45-degree field of view · image size 2352x1568: 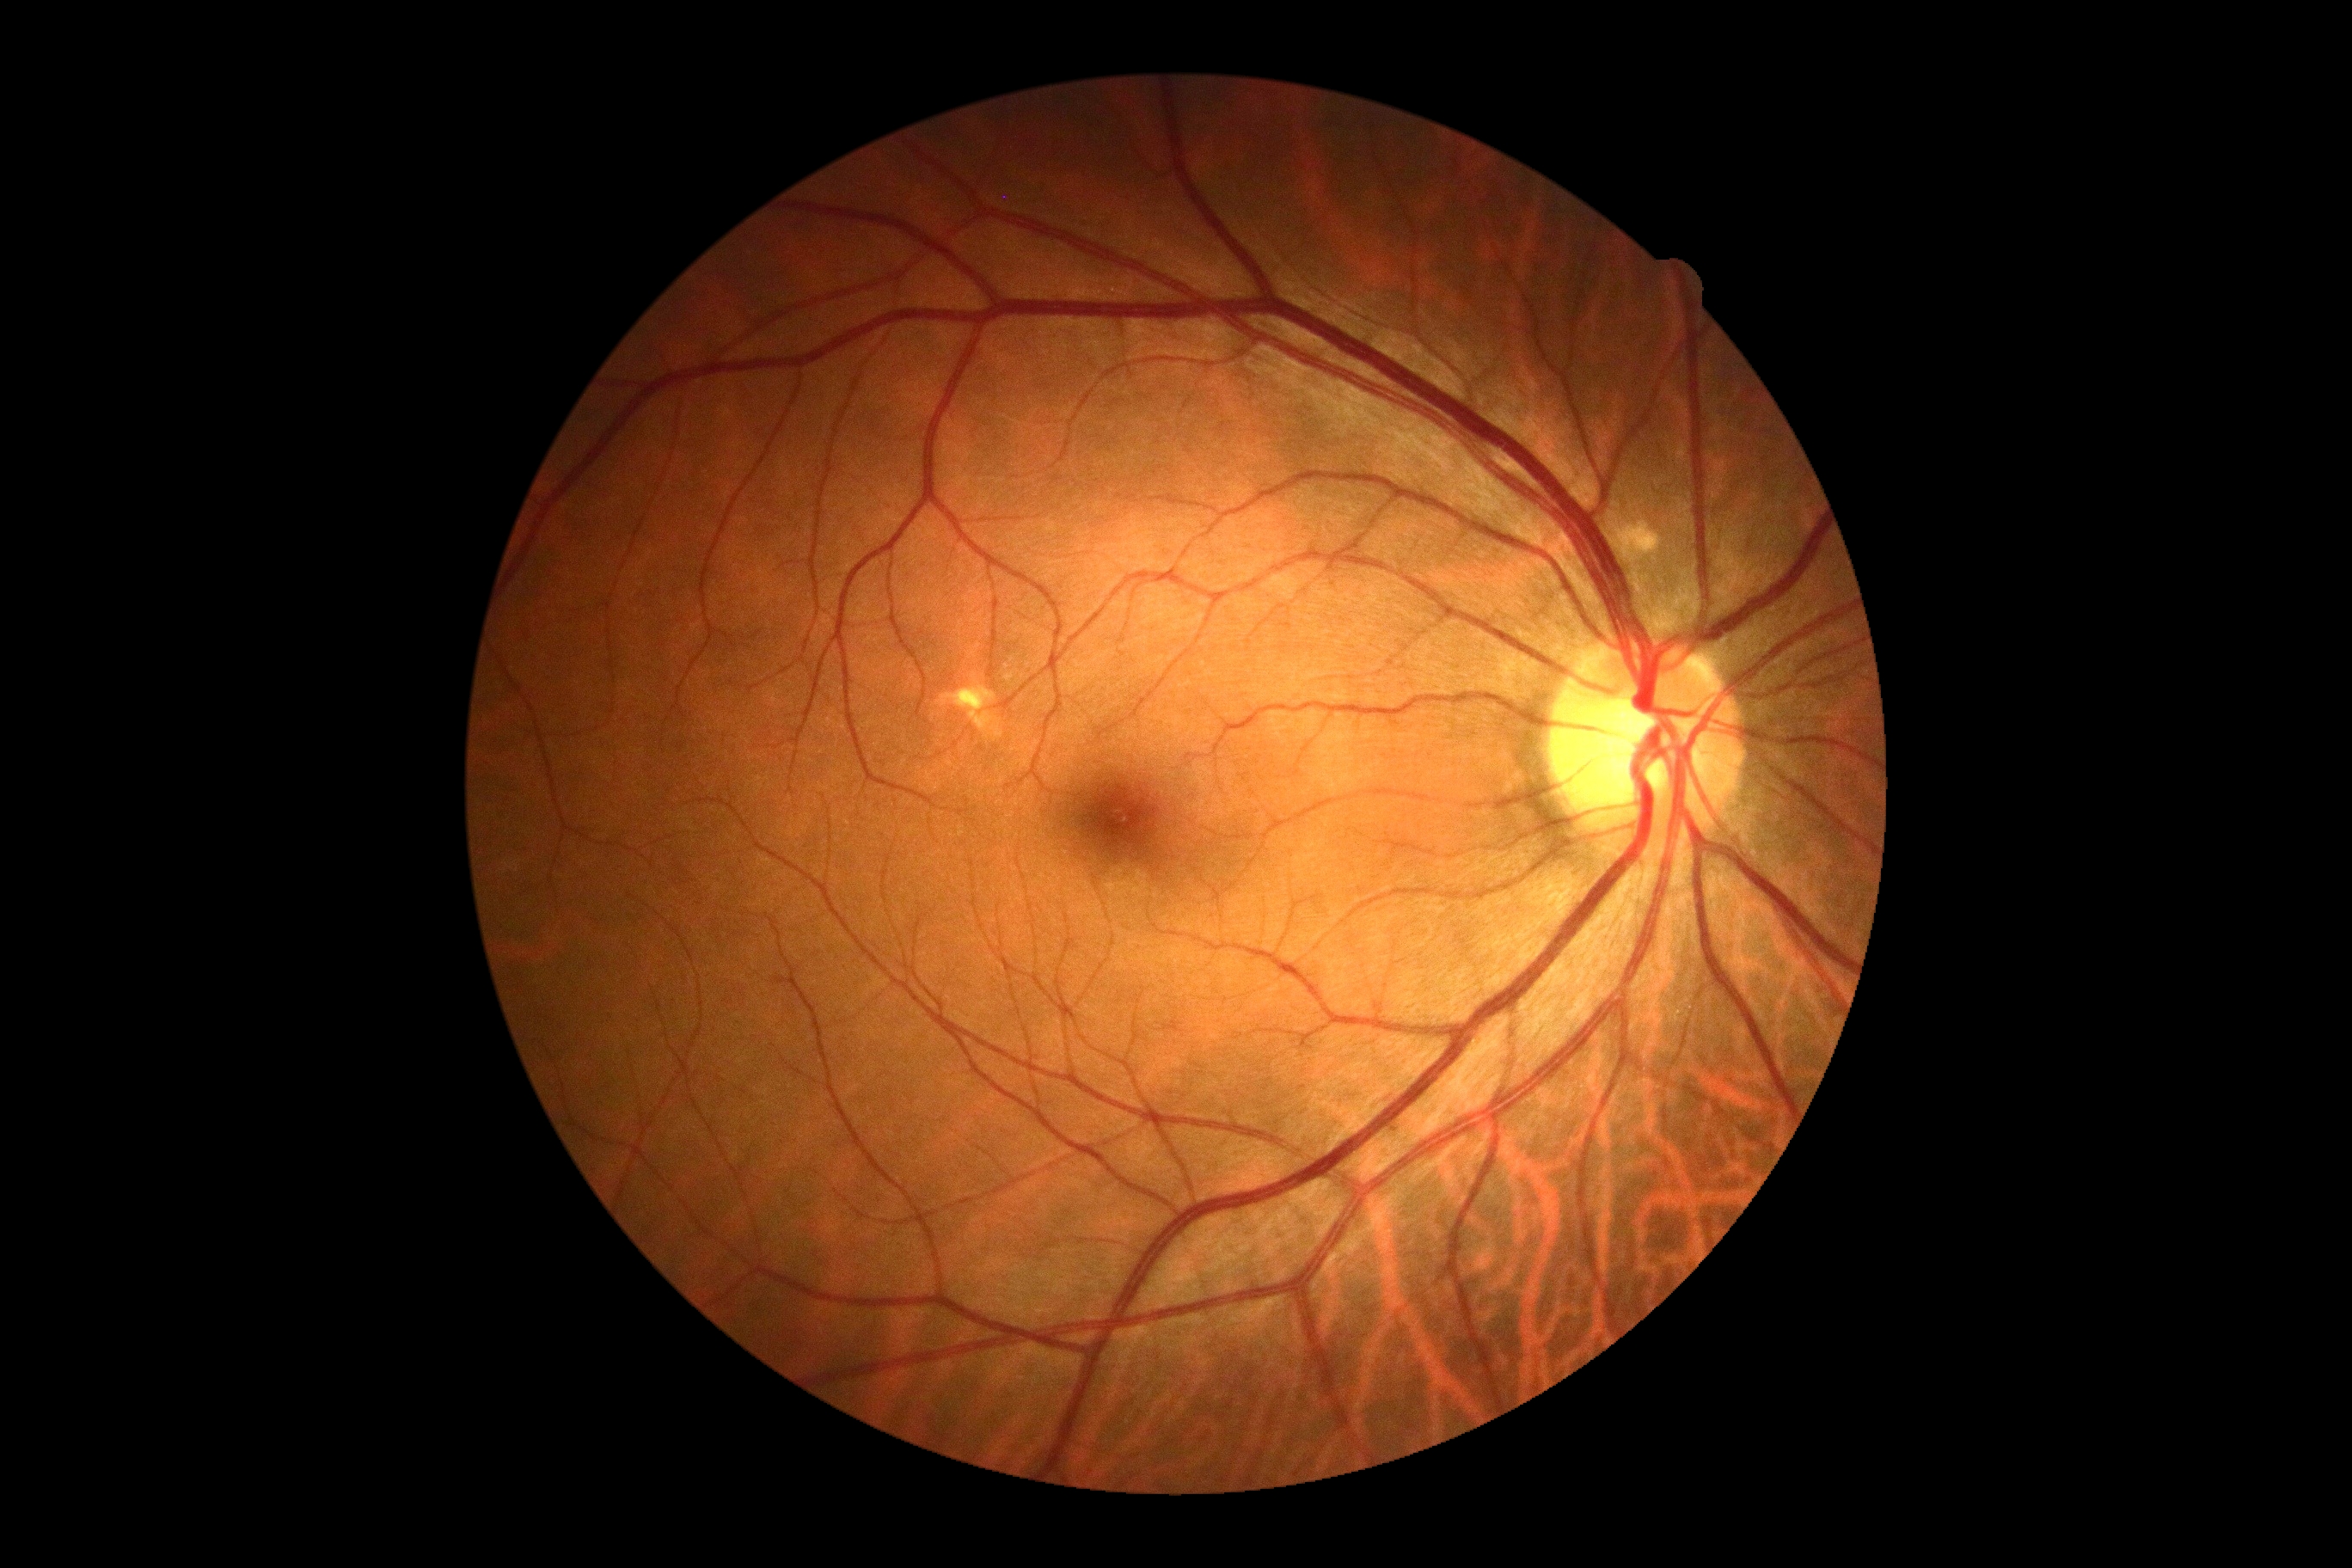

DR severity is 0.